DR severity per modified Davis staging: 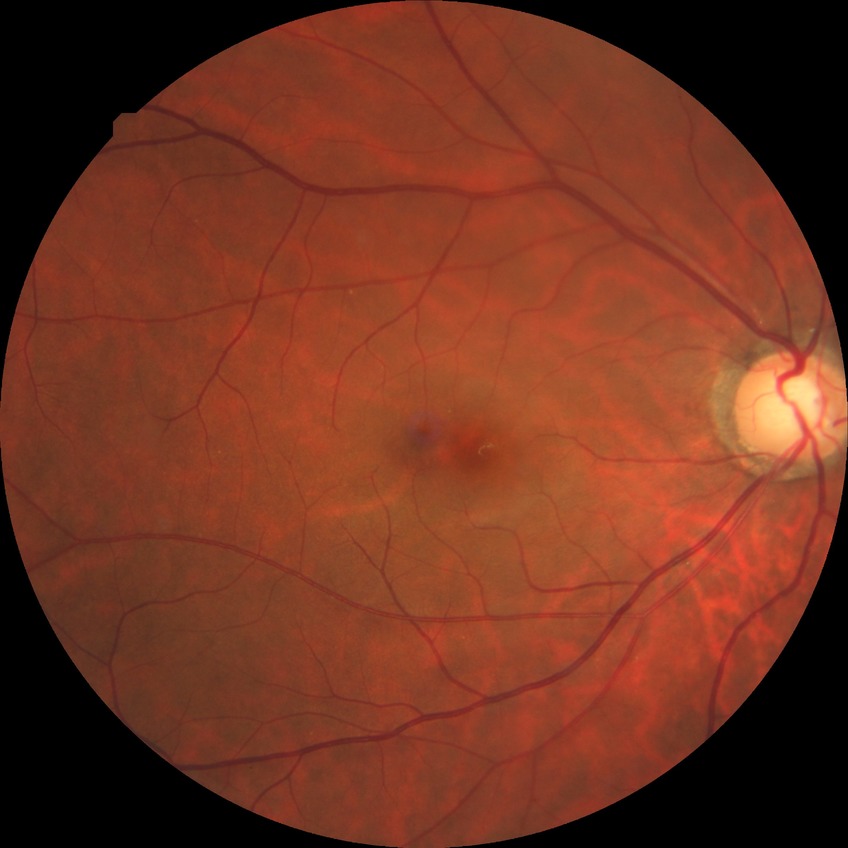

Annotations:
• Davis grade — NDR